1440 x 1080 pixels; Natus RetCam Envision, 130° FOV; pediatric retinal photograph (wide-field)
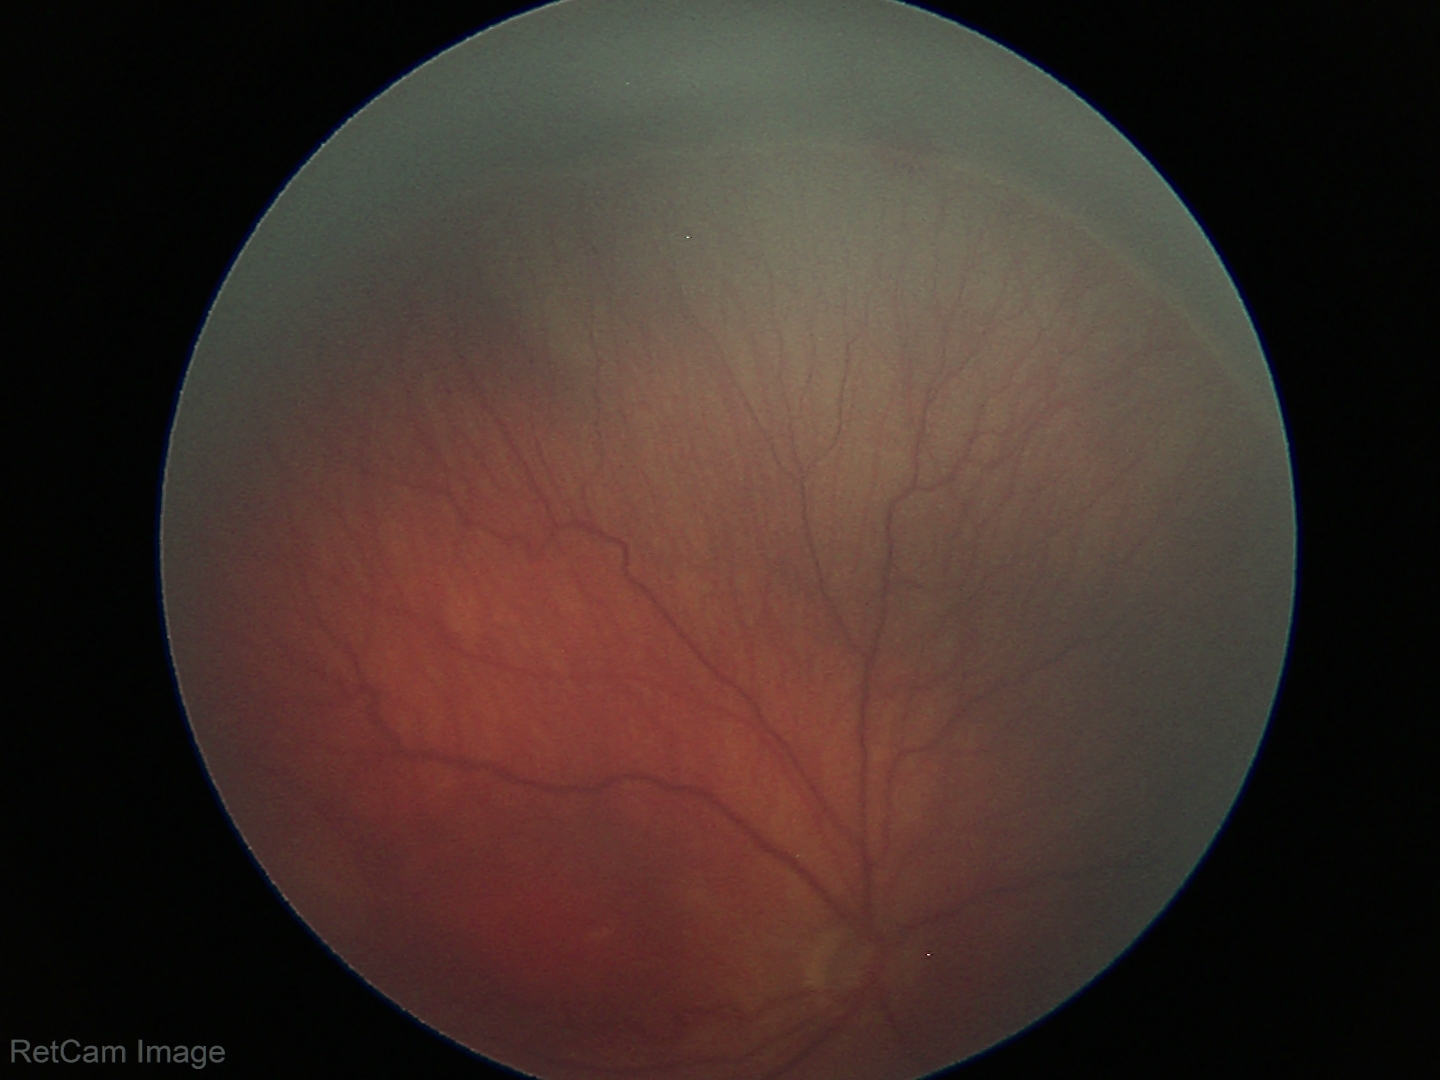 Without plus disease. Series diagnosed as retinopathy of prematurity (ROP) stage 3 — ridge with extraretinal fibrovascular proliferation.